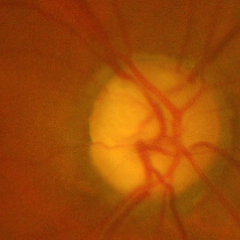

Demonstrates advanced-stage glaucoma.